Modified Davis grading
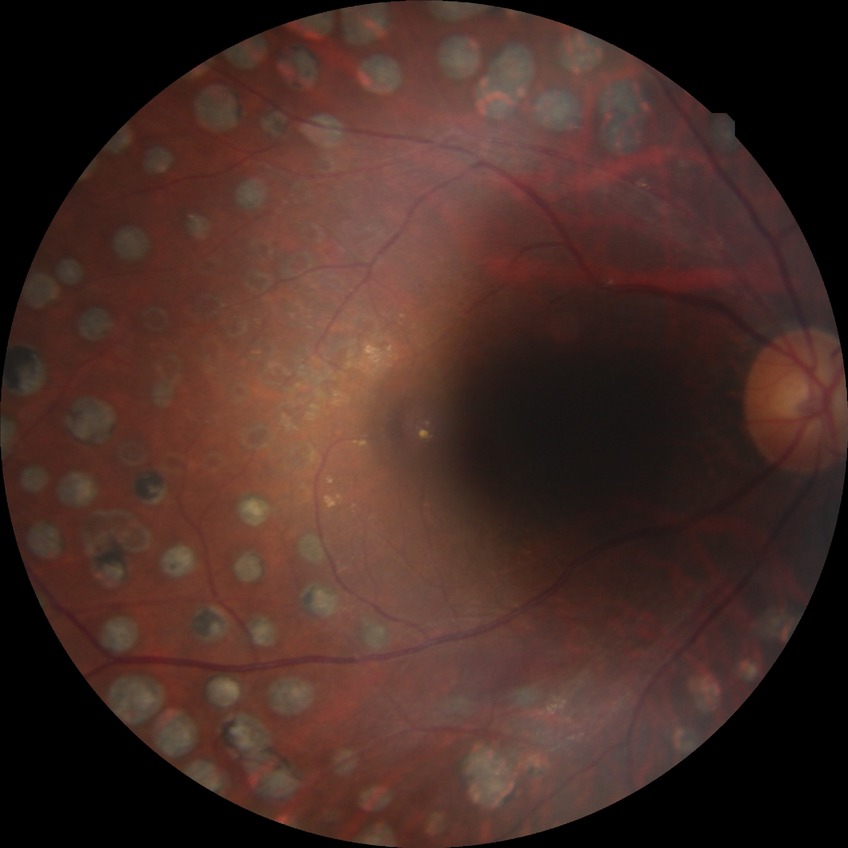 Retinopathy stage: proliferative diabetic retinopathy.